Davis DR grading, image size 848x848 — 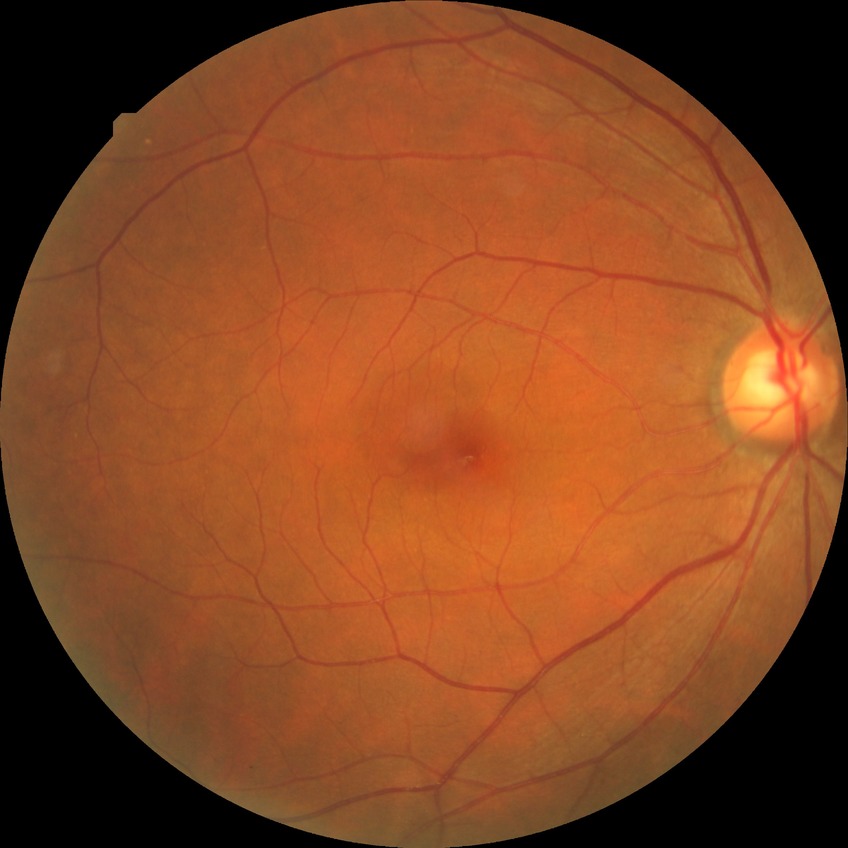

Diabetic retinopathy (DR) is no diabetic retinopathy (NDR).